Image size 1932x1916.
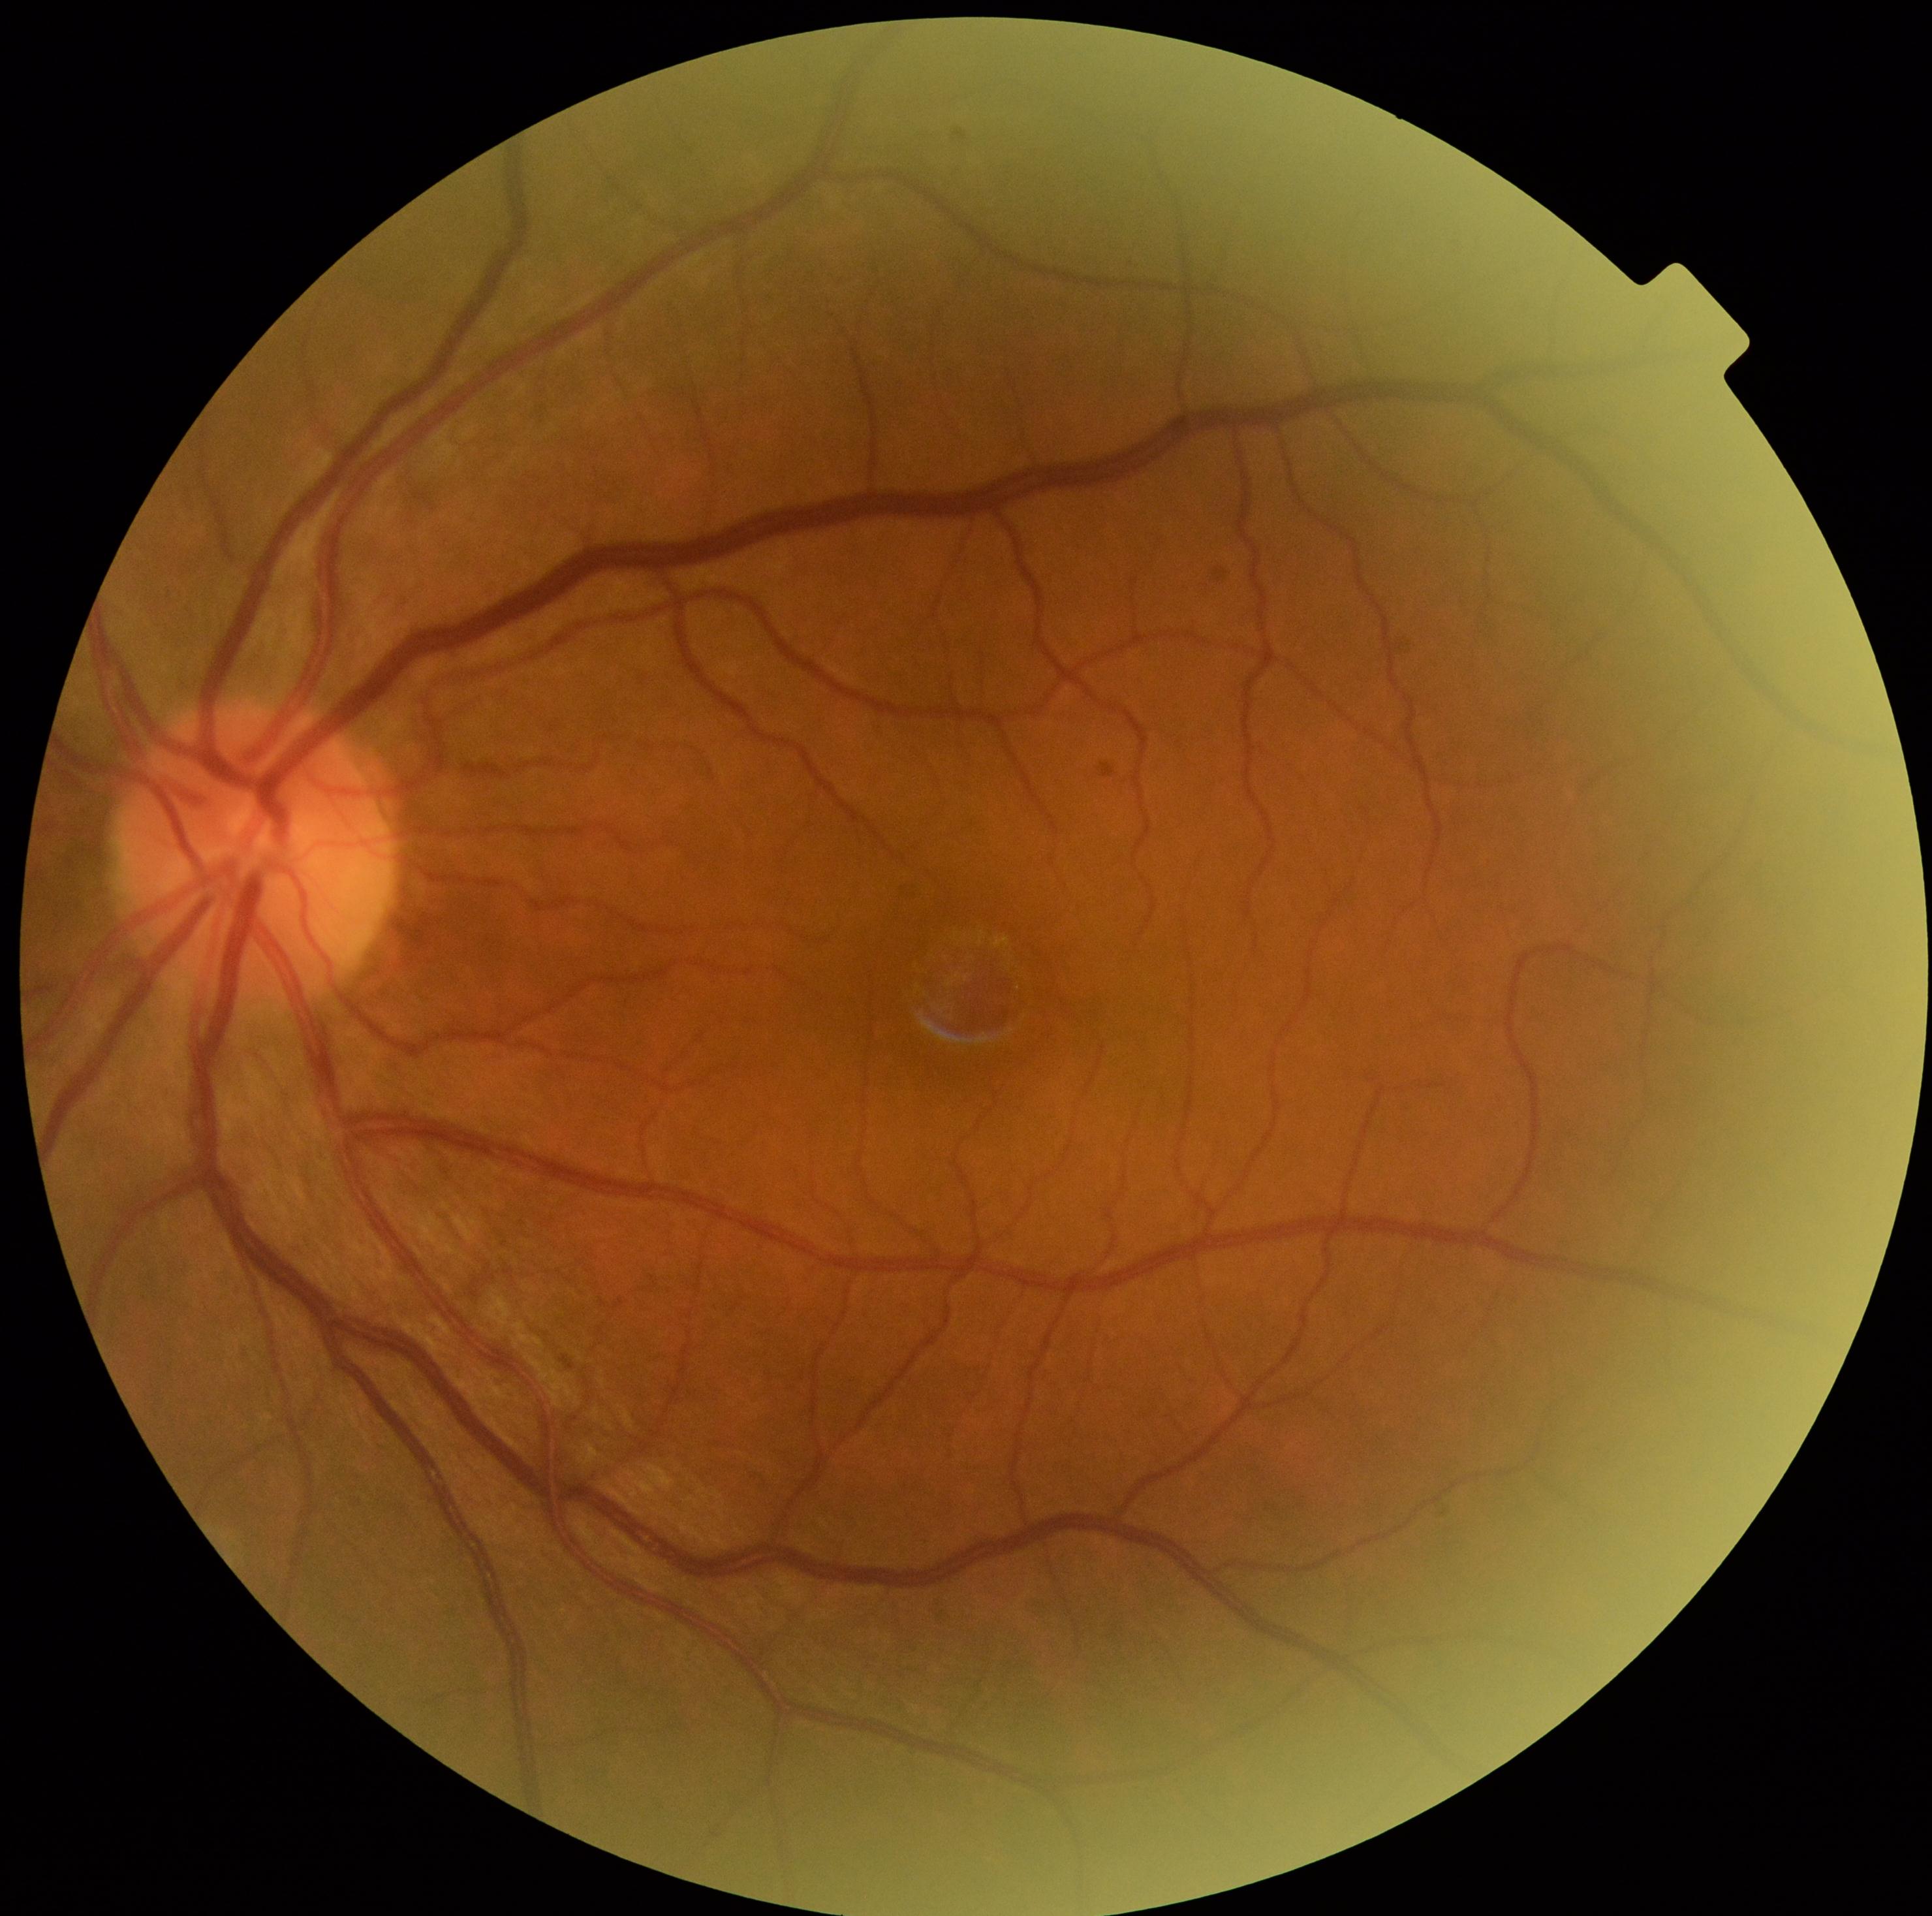

retinopathy grade: 0 — no visible signs of diabetic retinopathy.